Acquired on the Natus RetCam Envision · wide-field fundus image from infant ROP screening: 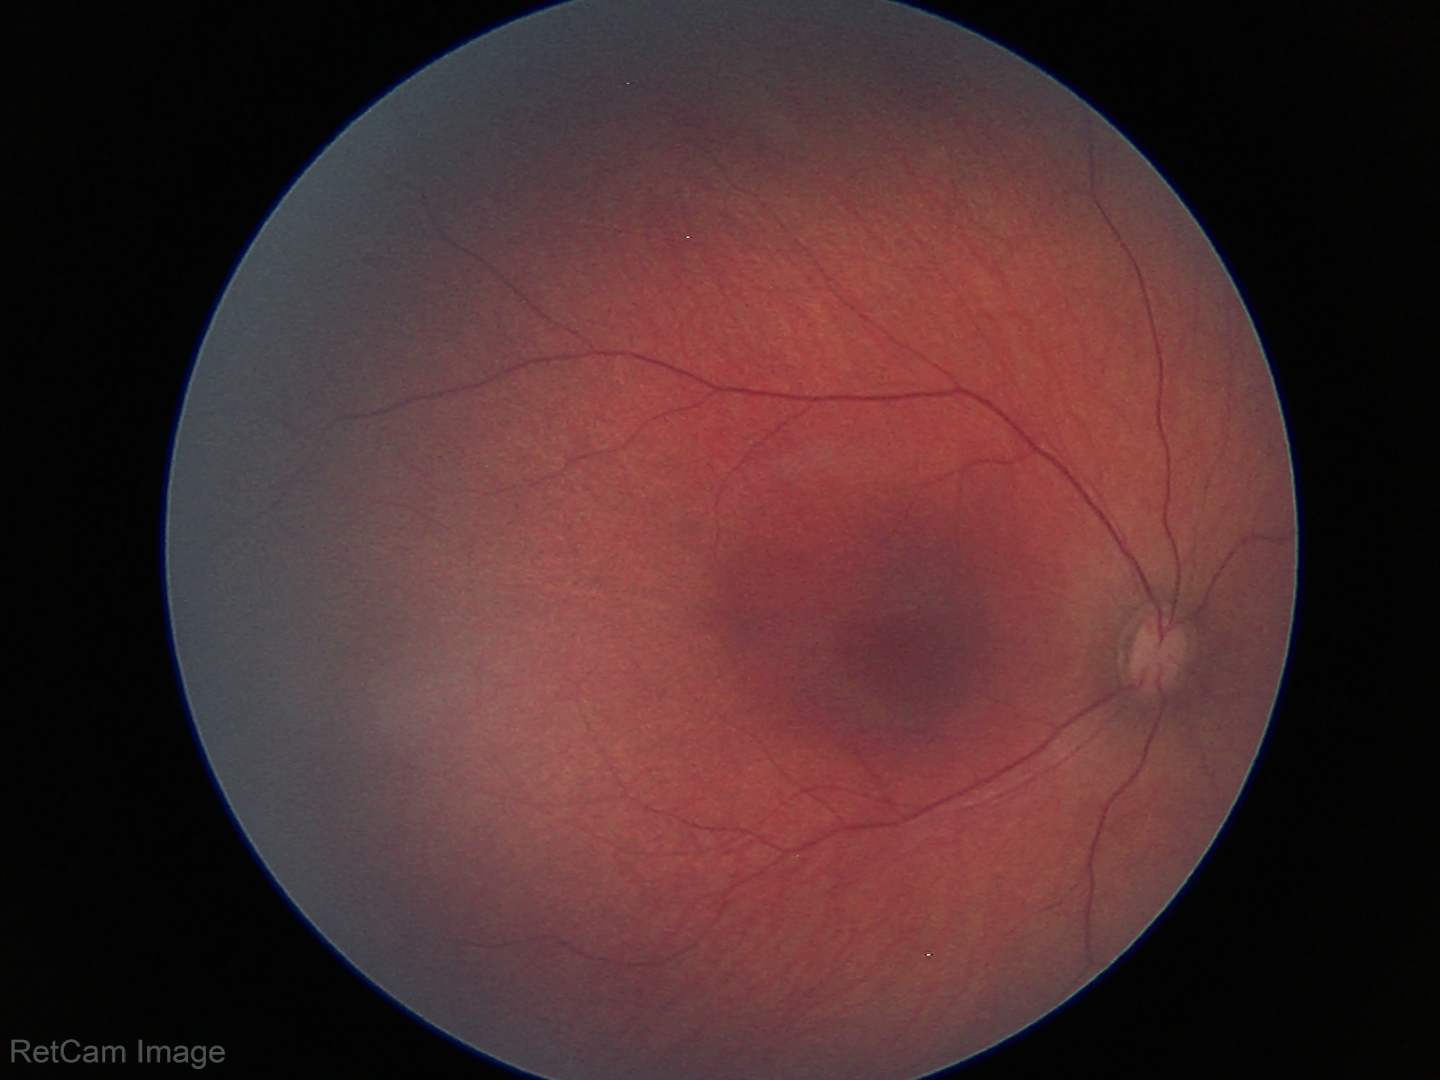
Physiological retinal appearance for postconceptual age.